CFP: 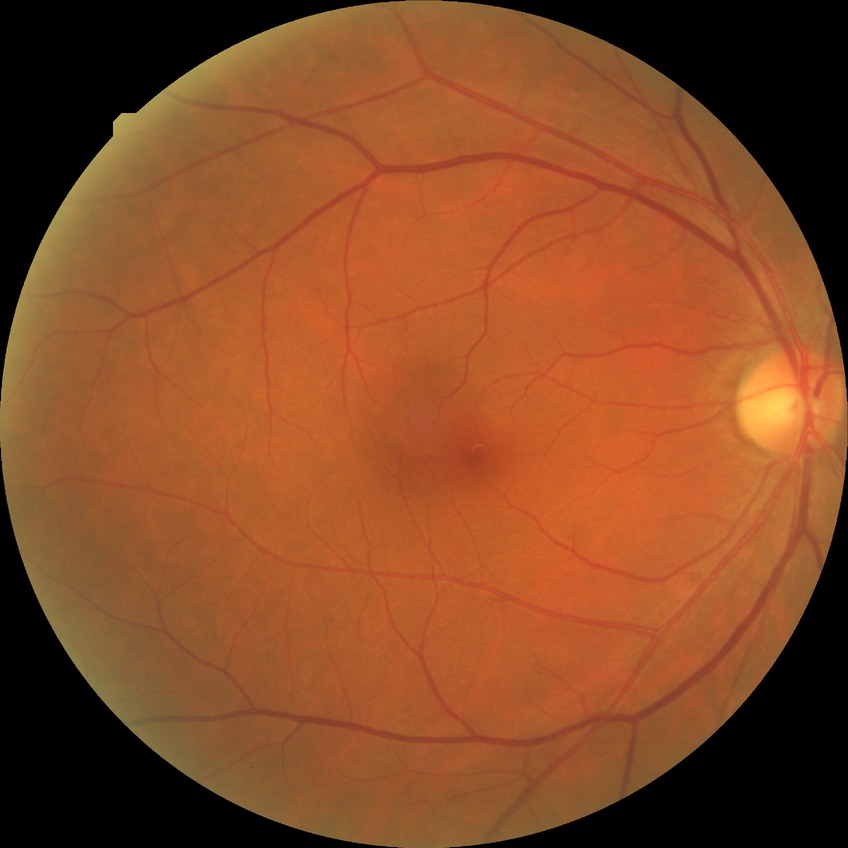

  davis_grade: NDR